Image size 848x848: 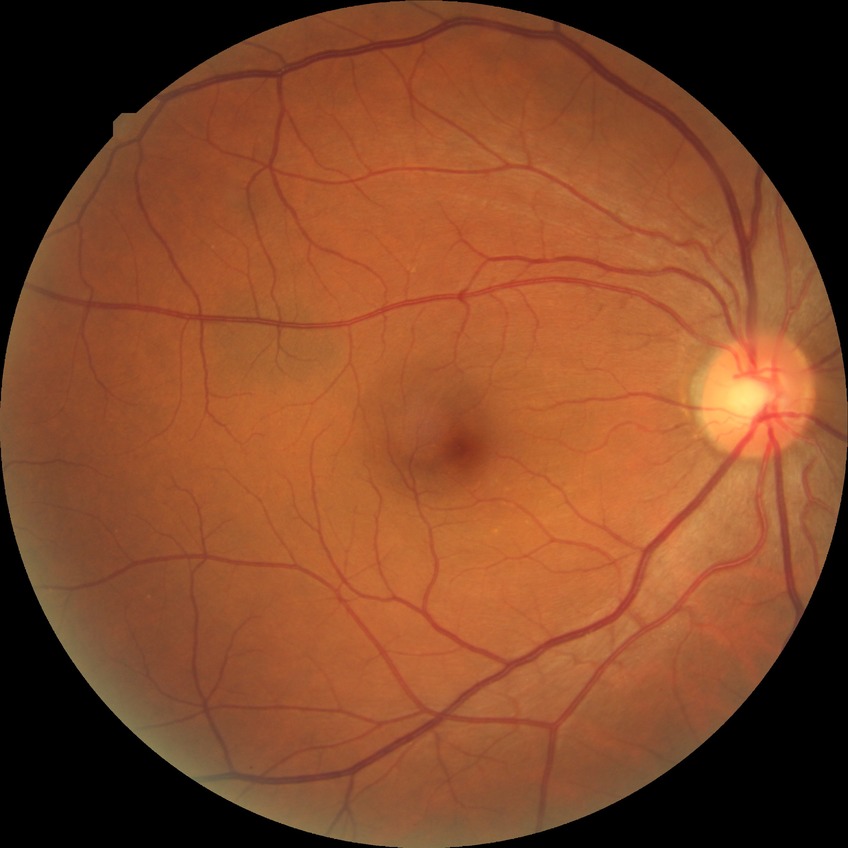
{
  "davis_grade": "no diabetic retinopathy"
}